45-degree field of view.
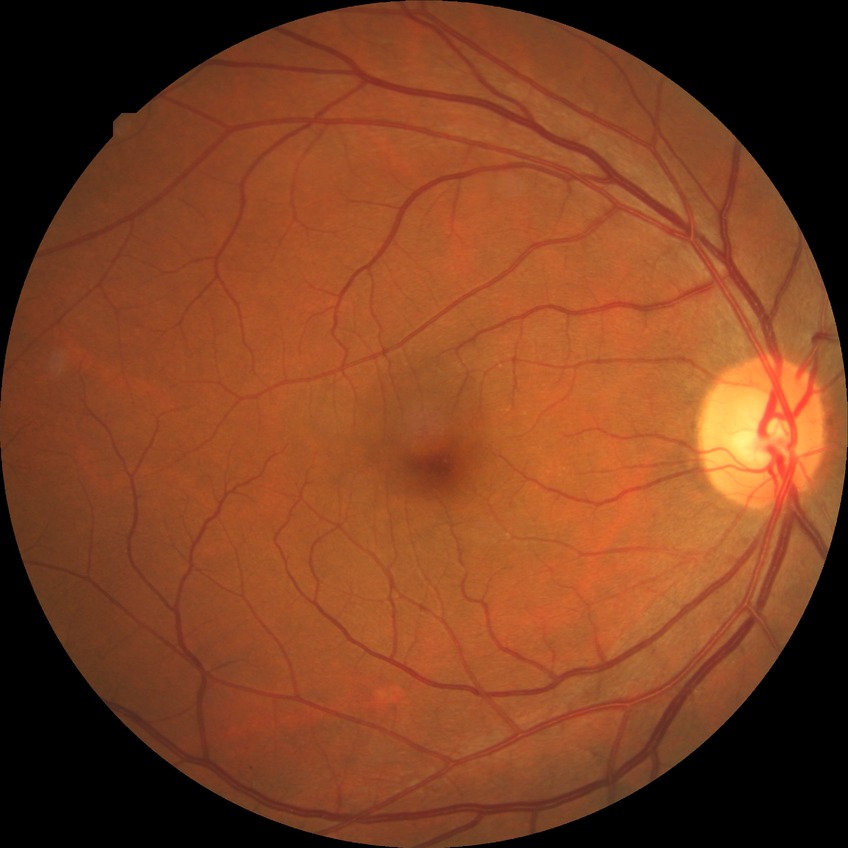

- diabetic retinopathy (DR): no diabetic retinopathy (NDR)